2352 x 1568 pixels — 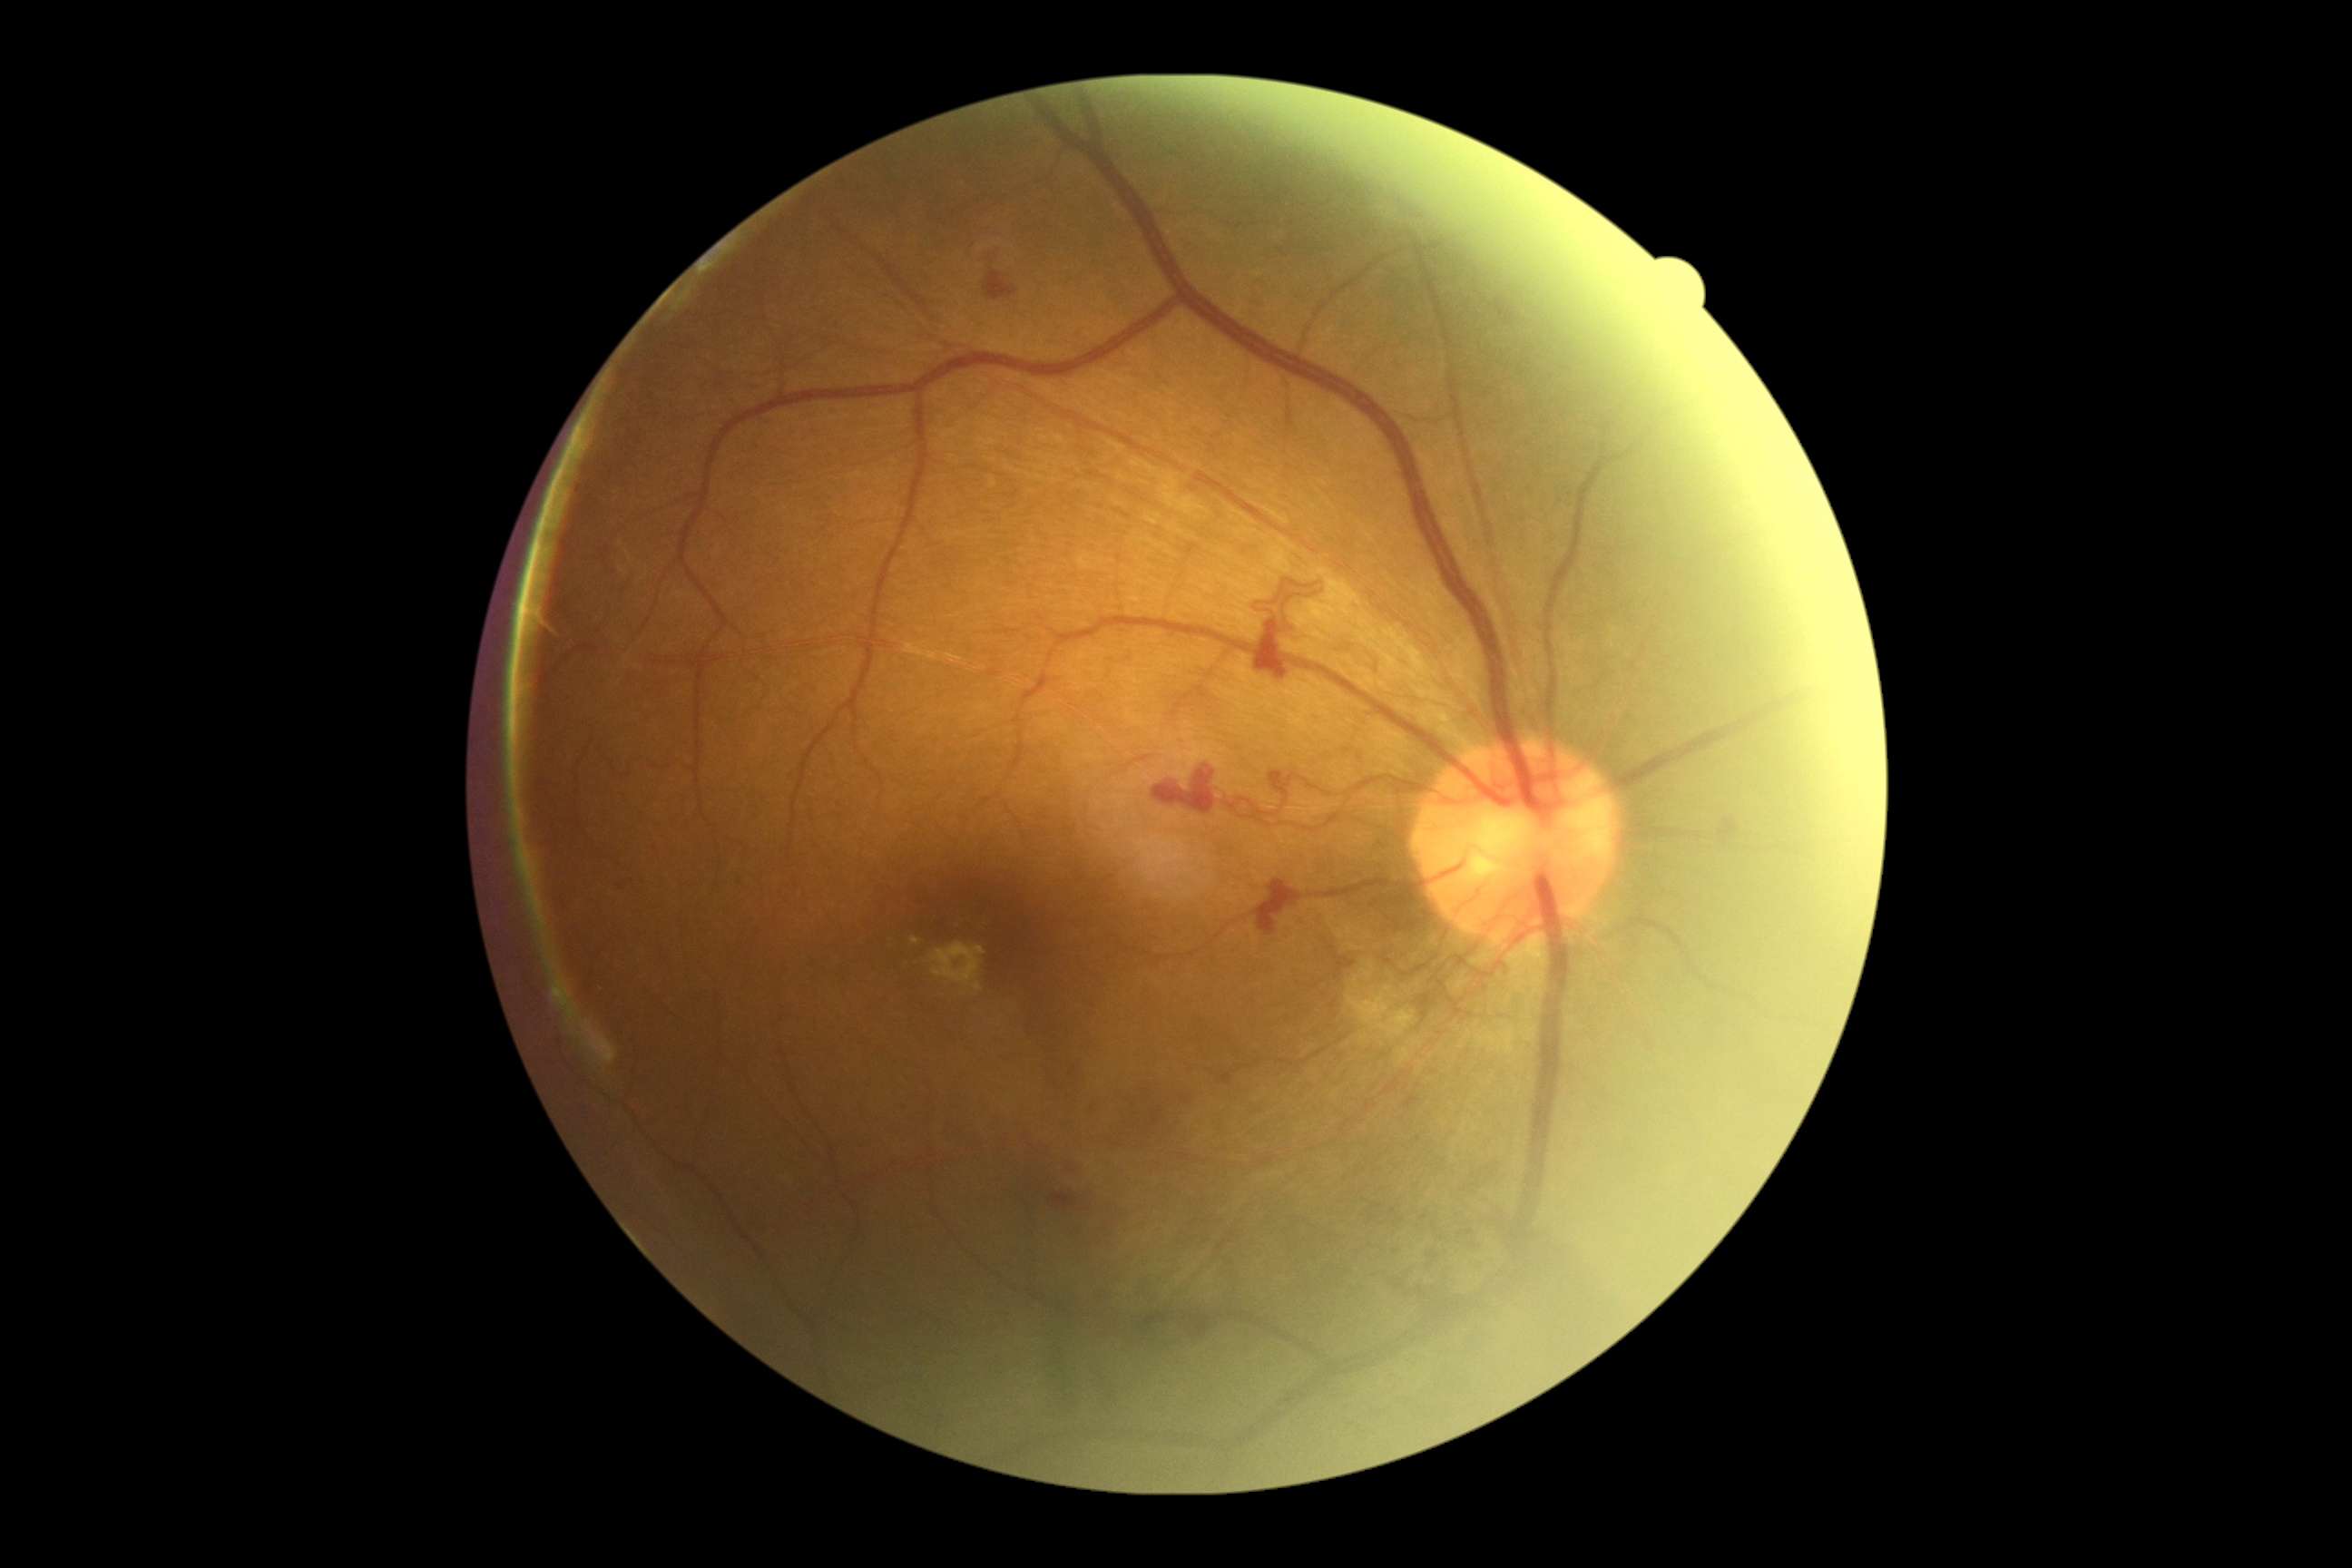
{
  "dr_grade": "4/4 — neovascularization and/or vitreous/pre-retinal hemorrhage"
}